848 by 848 pixels.
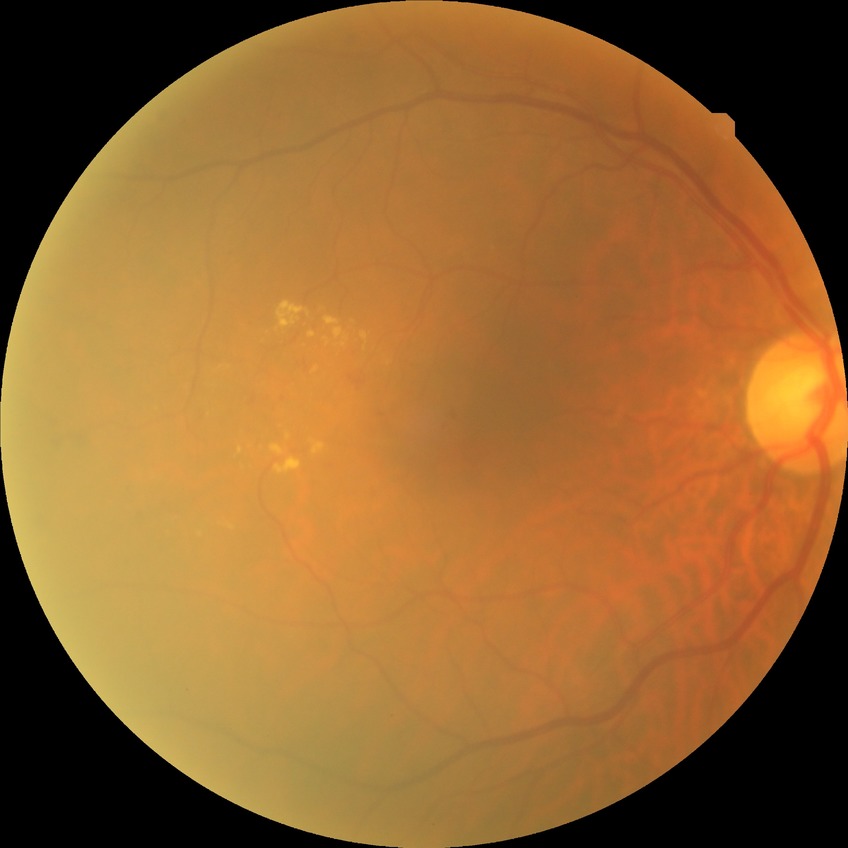 diabetic retinopathy (DR)=SDR (simple diabetic retinopathy).